2352x1568.
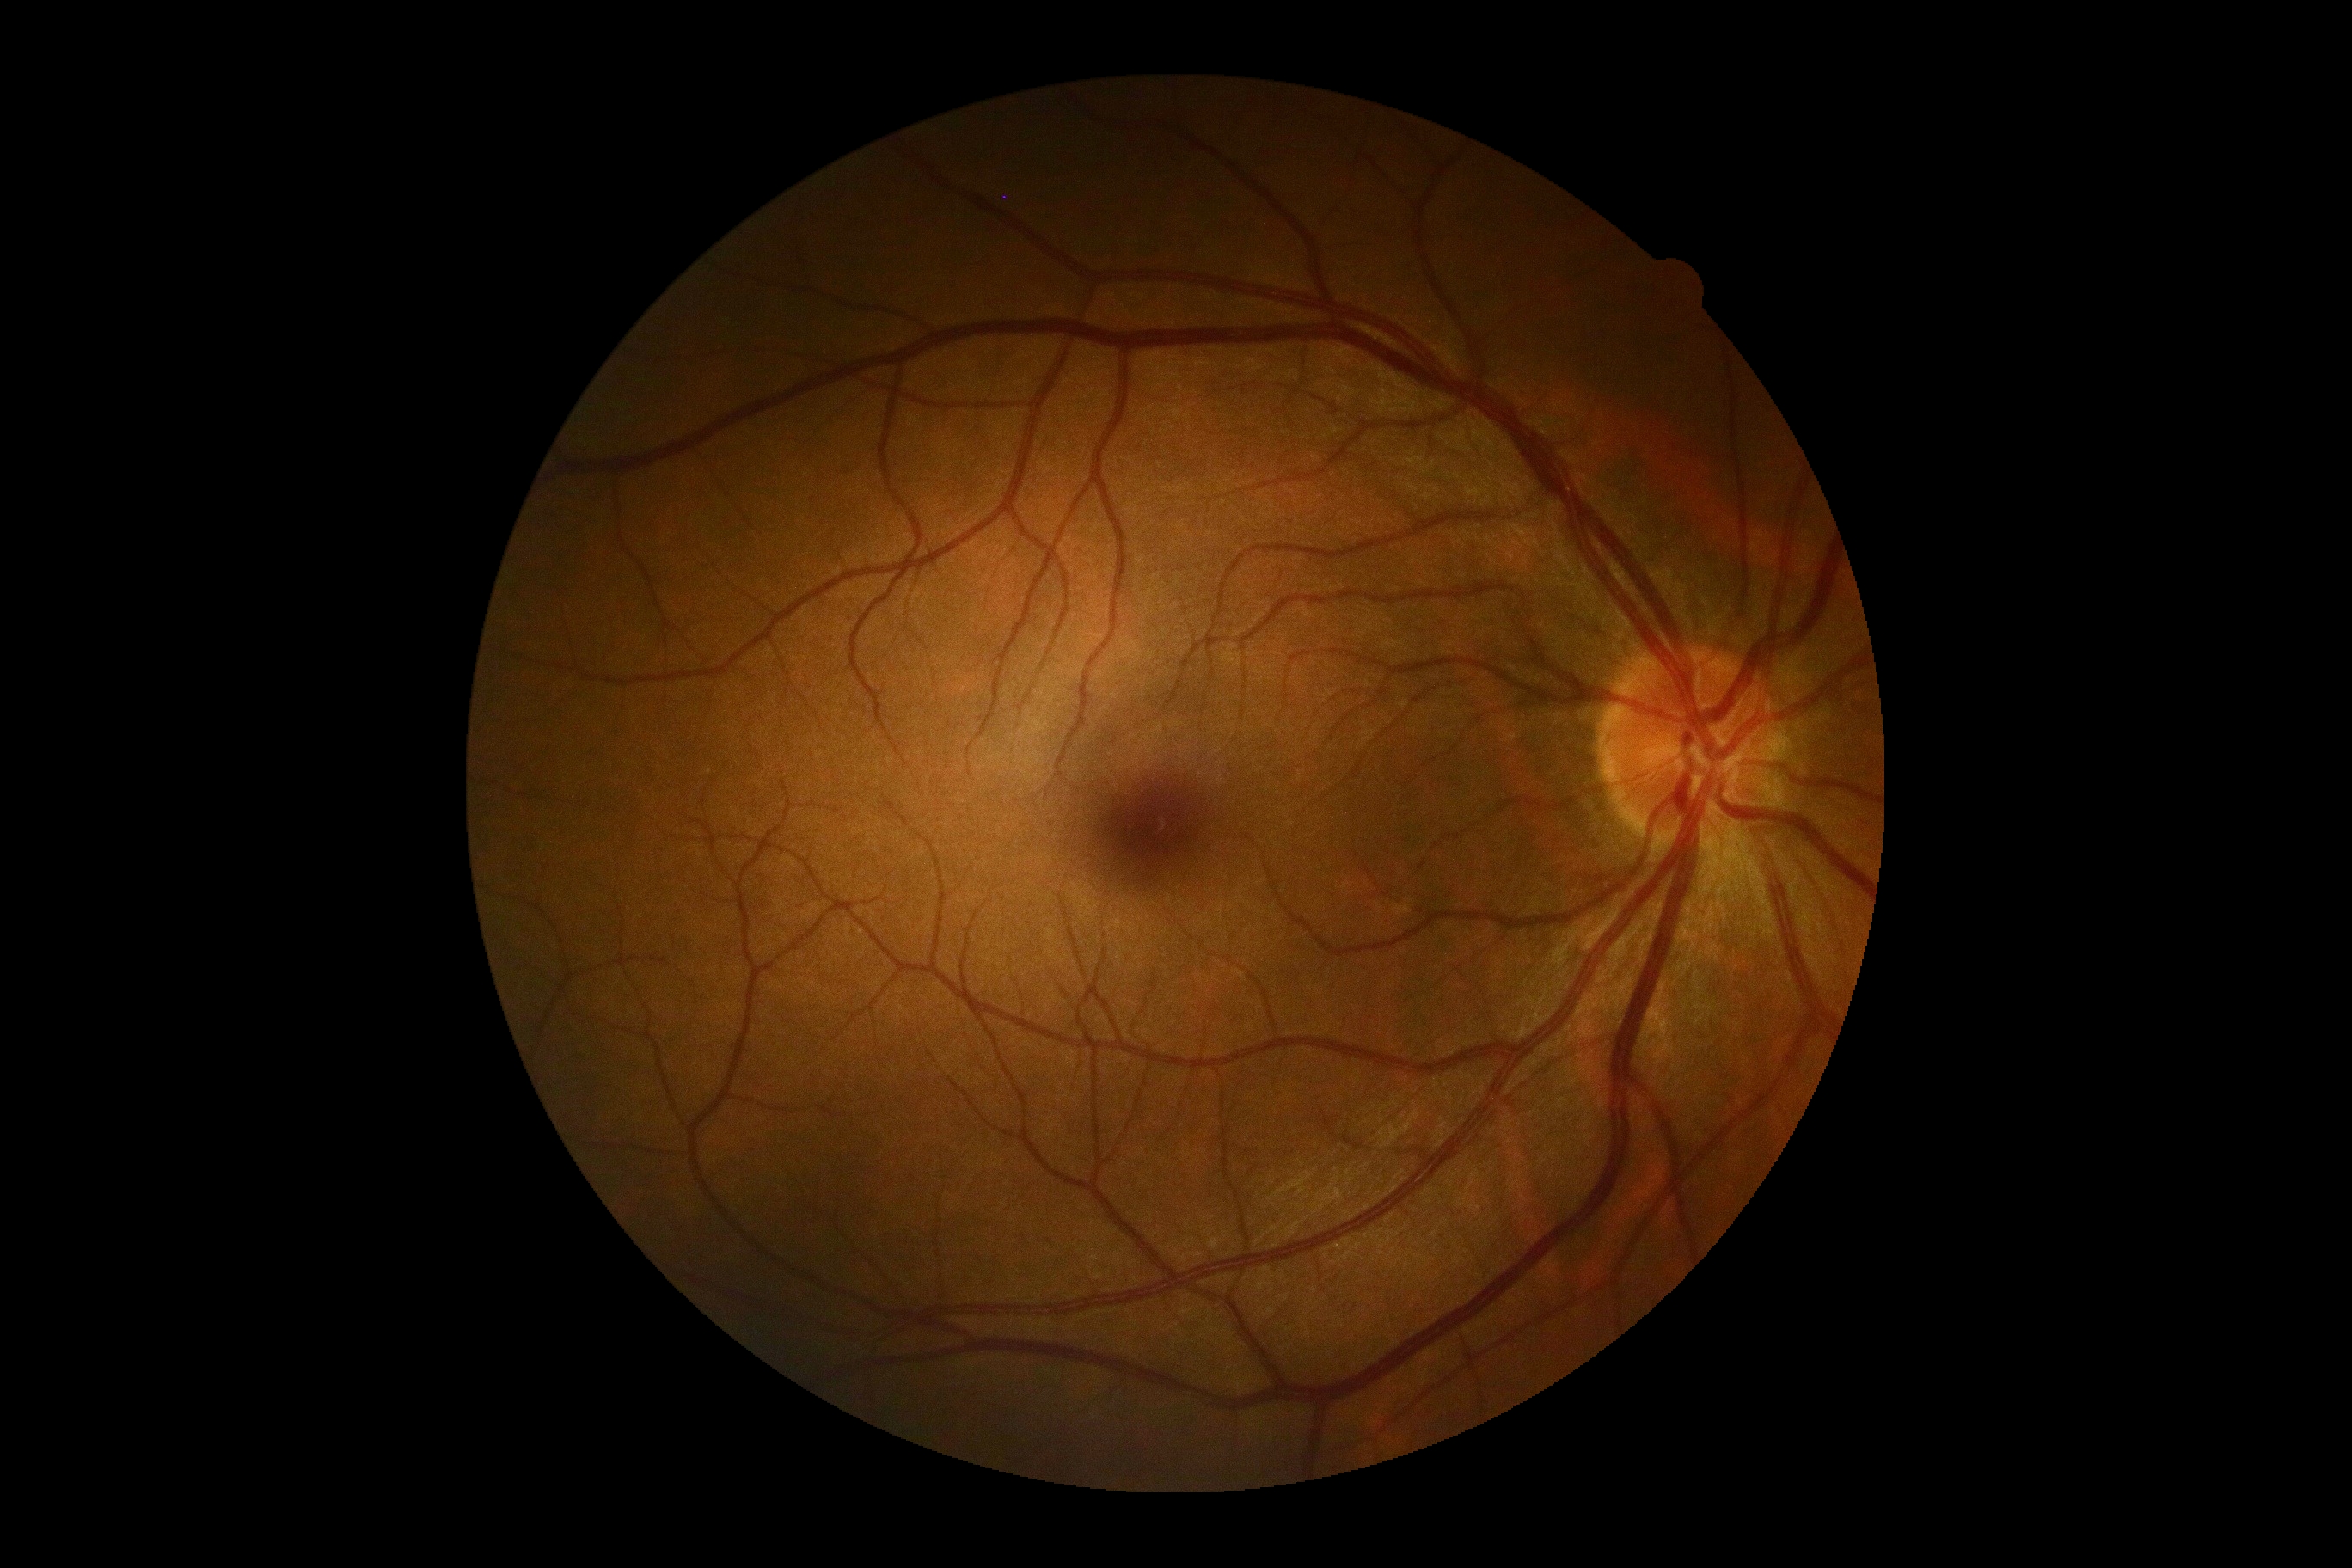
No apparent diabetic retinopathy.
DR is 0/4 — no visible signs of diabetic retinopathy.